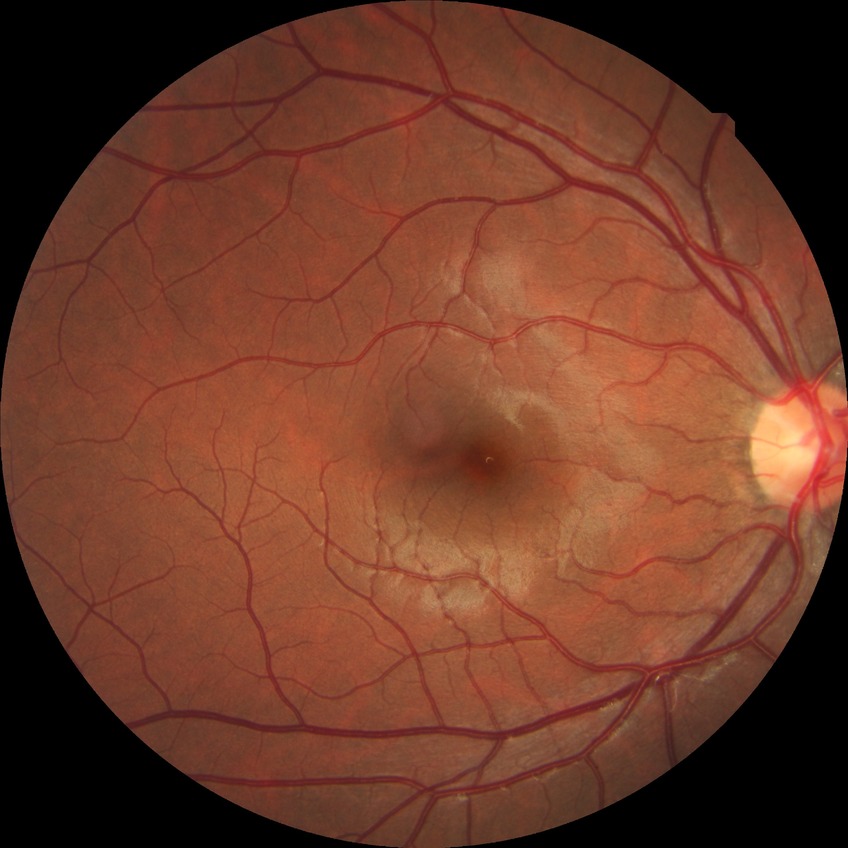 DR stage: NDR; DR impression: no DR findings.